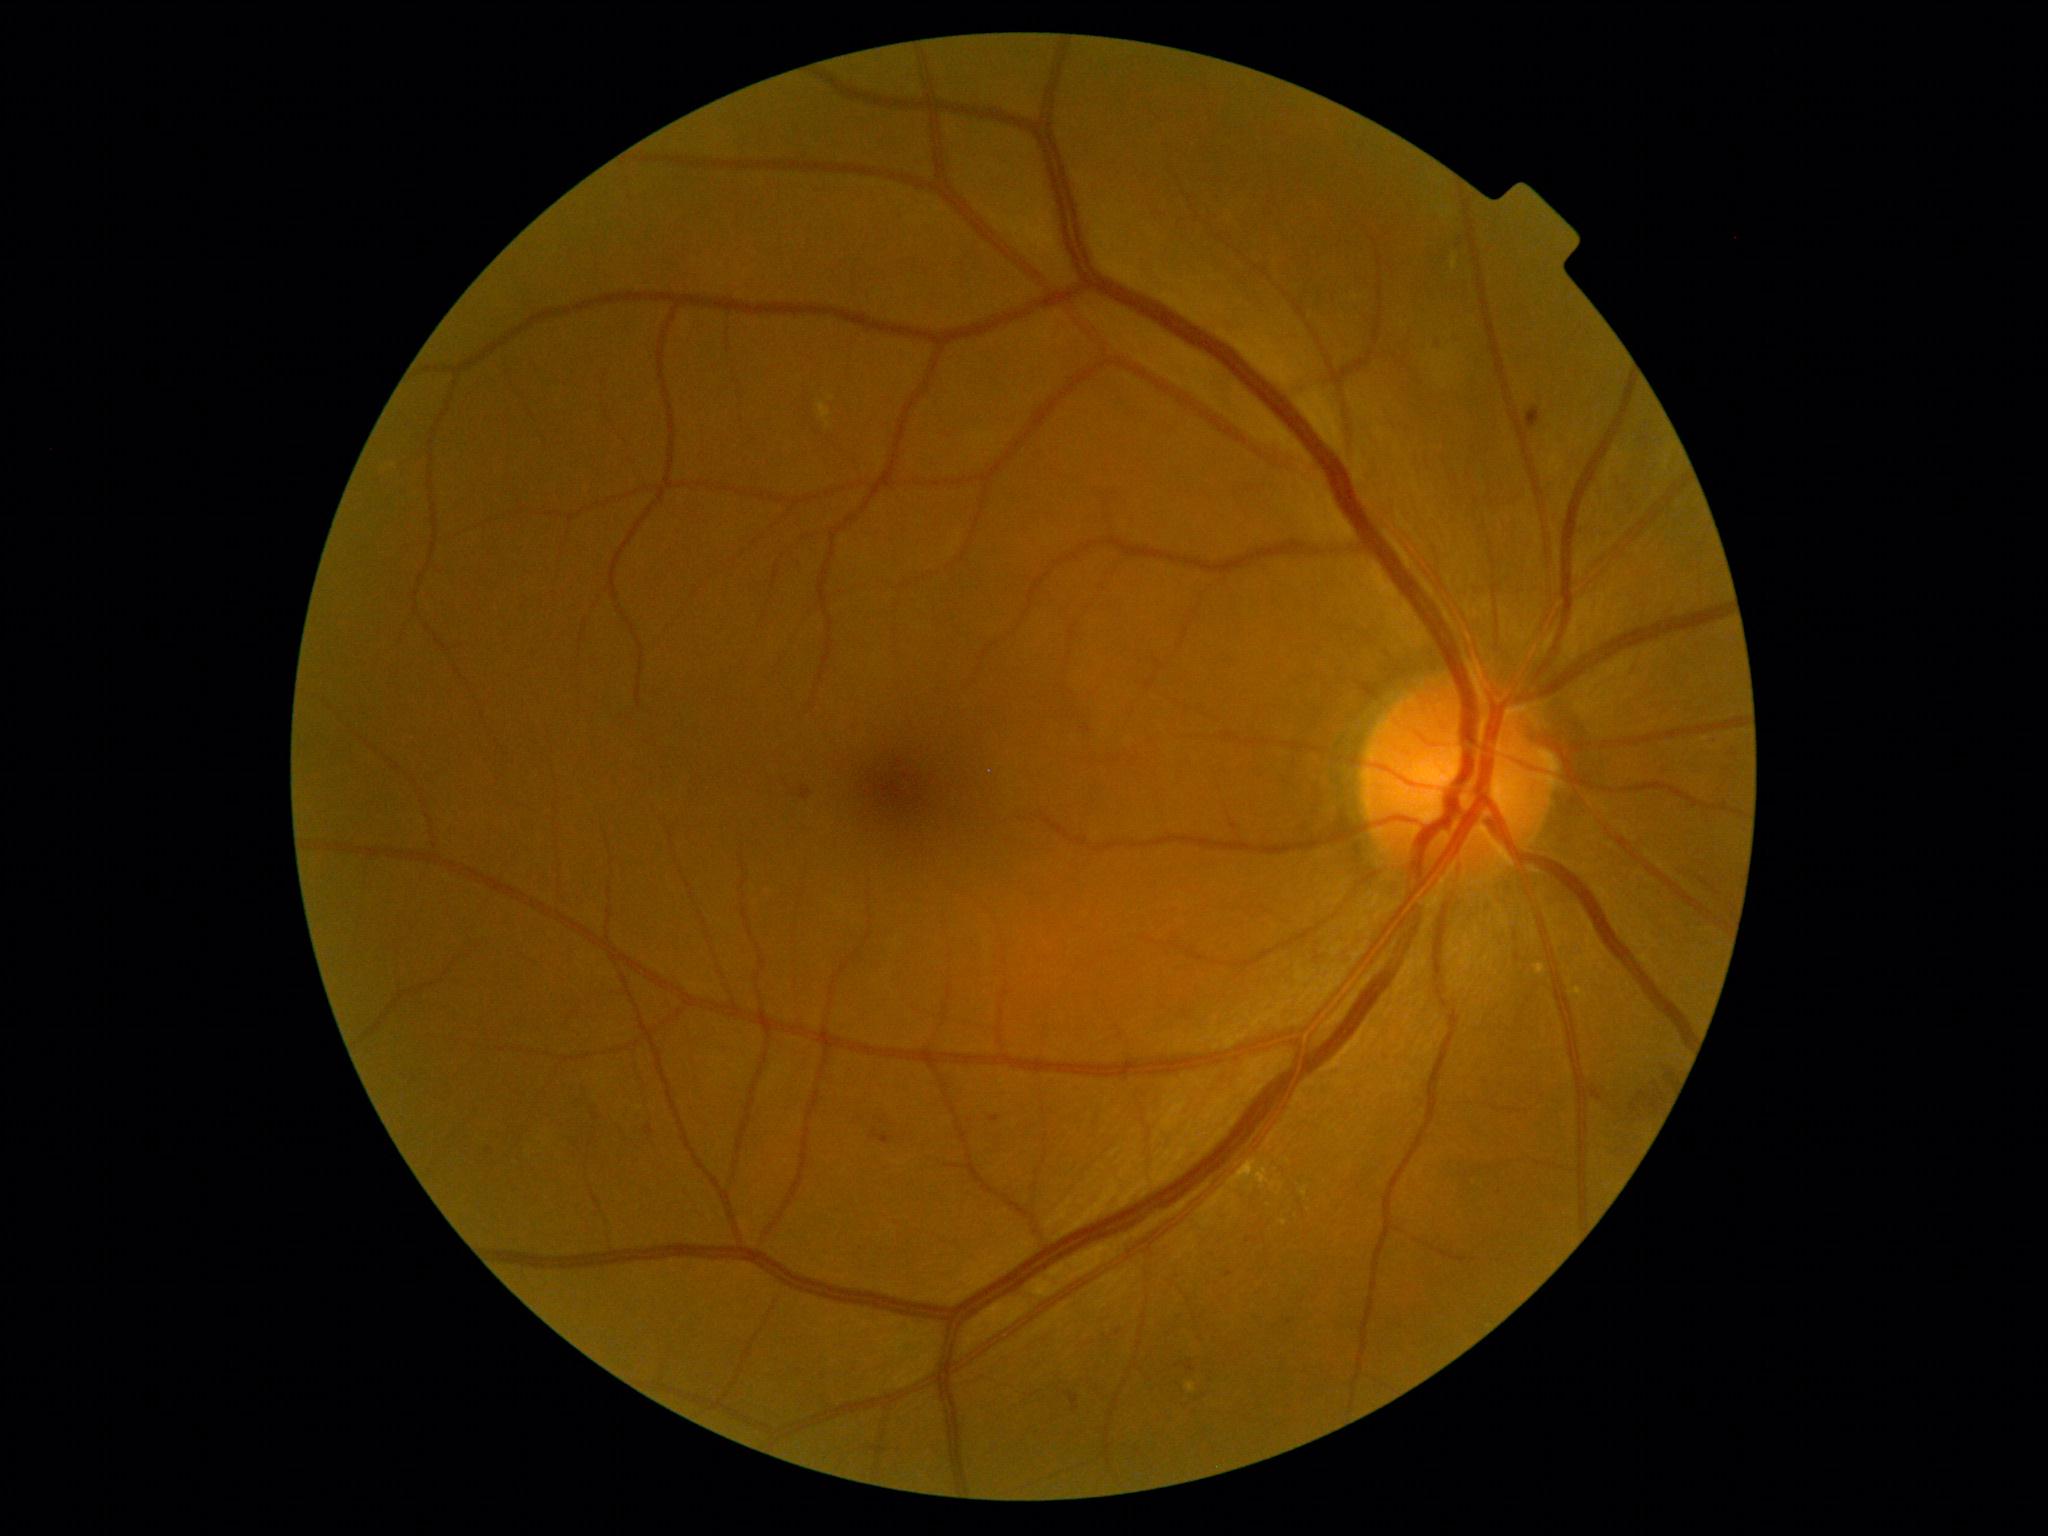
* diabetic retinopathy grade: 2